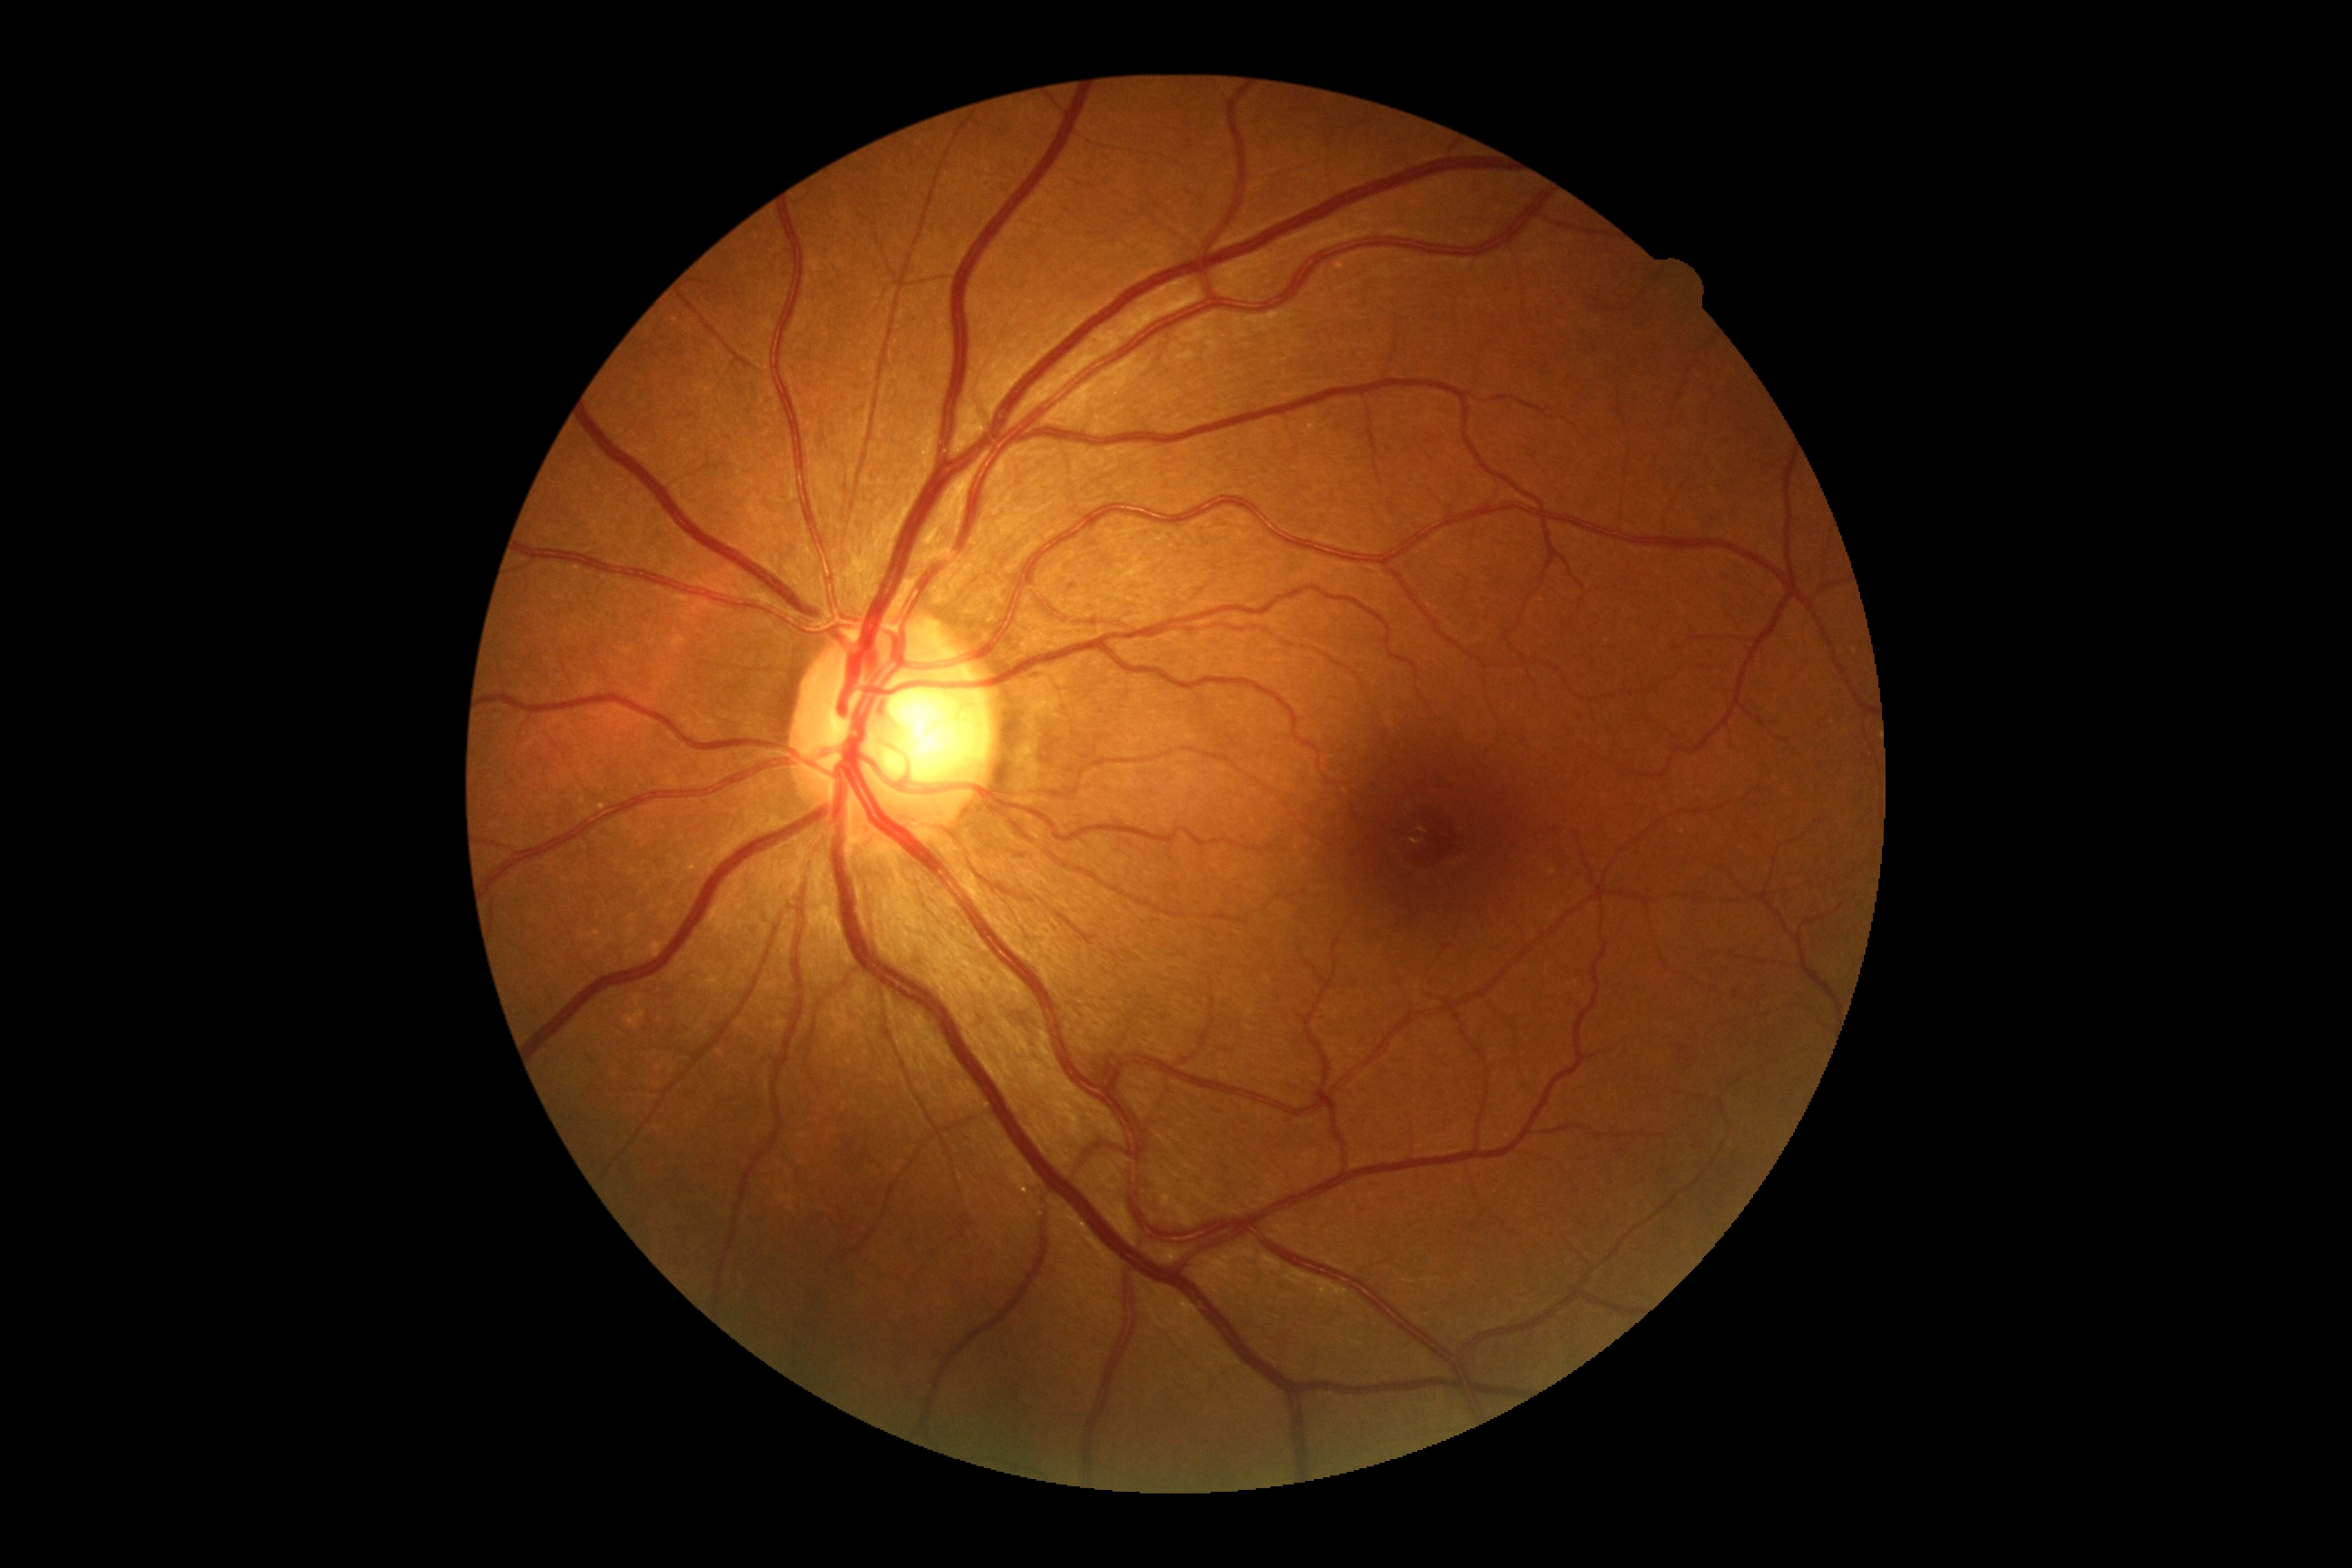 DR severity: grade 0 (no apparent retinopathy).